Acquired with a NIDEK AFC-230. 45° FOV: 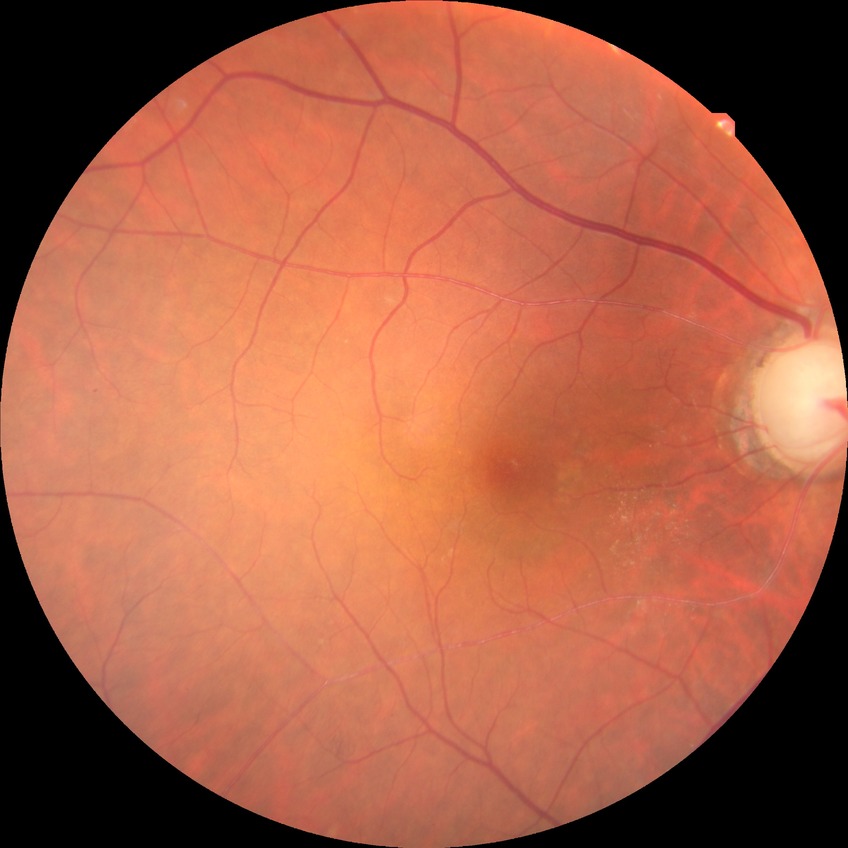
Modified Davis classification: simple diabetic retinopathy.